Tabletop color fundus camera image. Image size 412x310. 45-degree field of view.
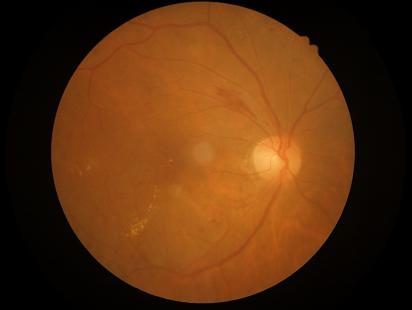 Overall quality is good and the image is gradable.
No noticeable blur.
Adequate contrast for distinguishing structures.
Illumination and color balance are good.